Acquired with a Topcon TRC; optic disc region of a color fundus photo; 1393 by 1393 pixels — 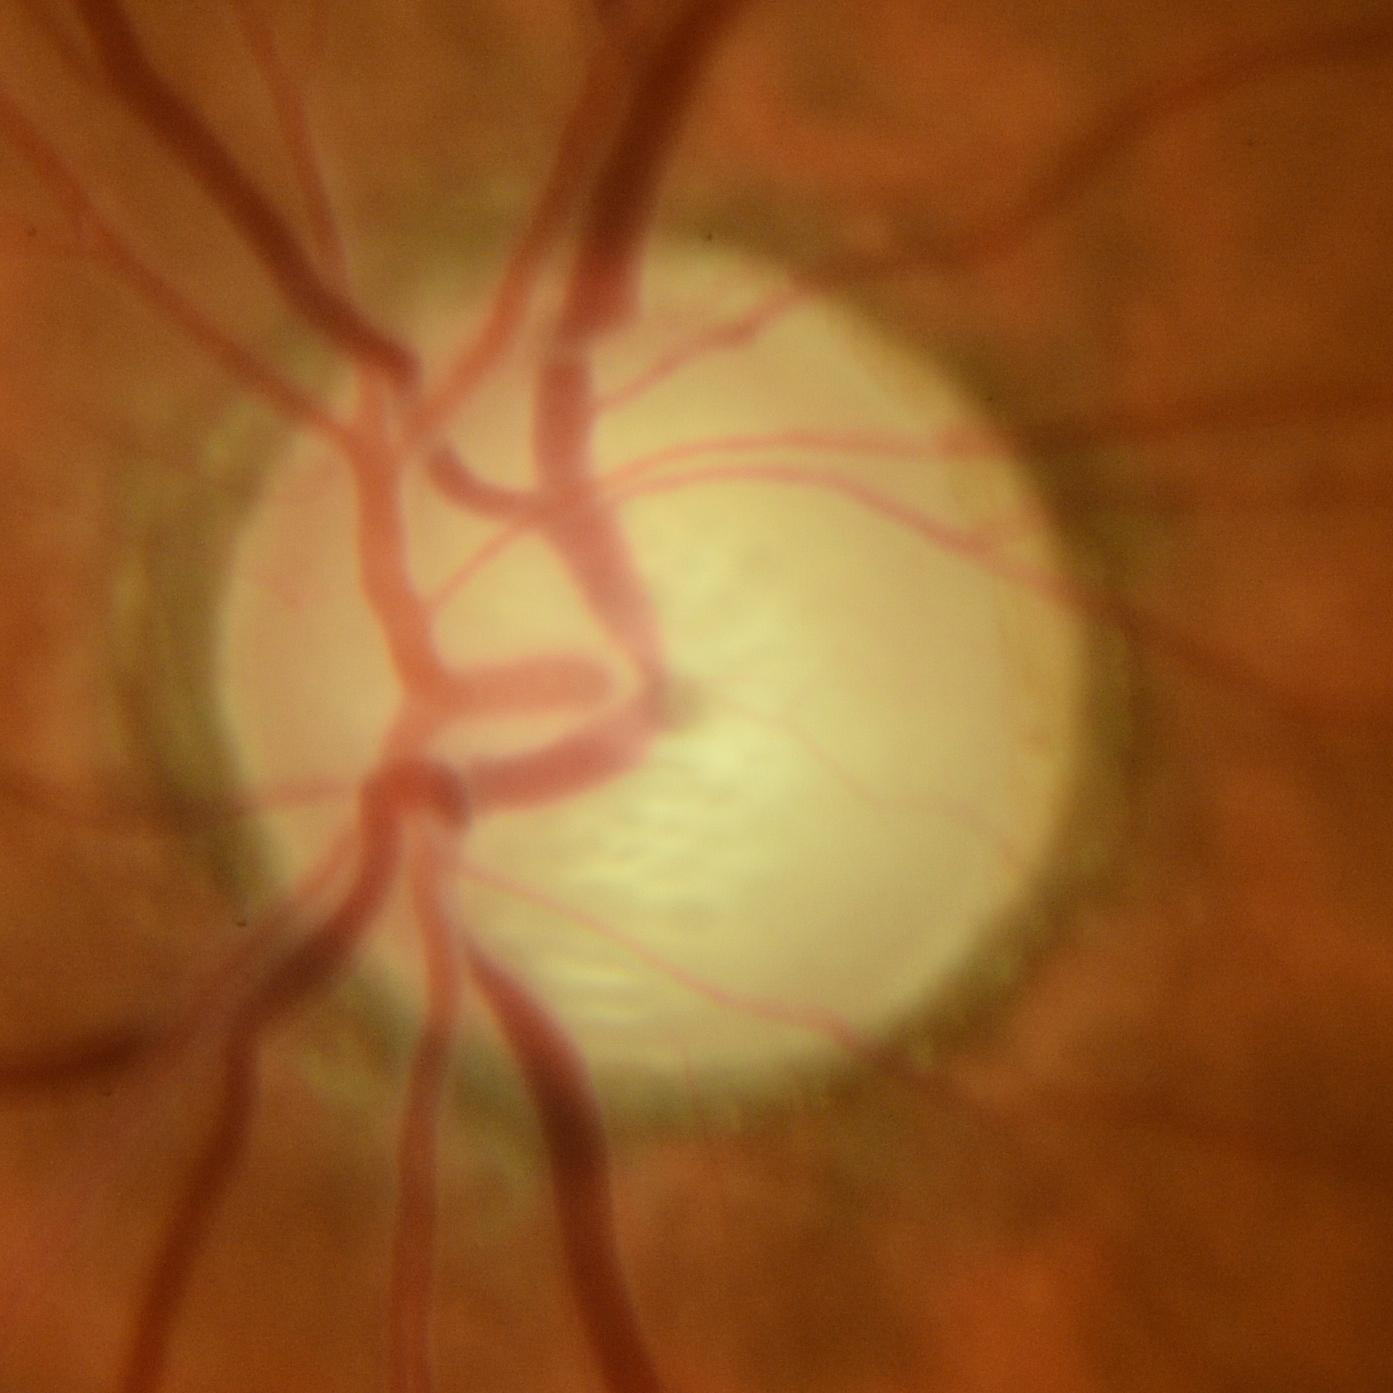

Diagnosis: glaucomatous findings.